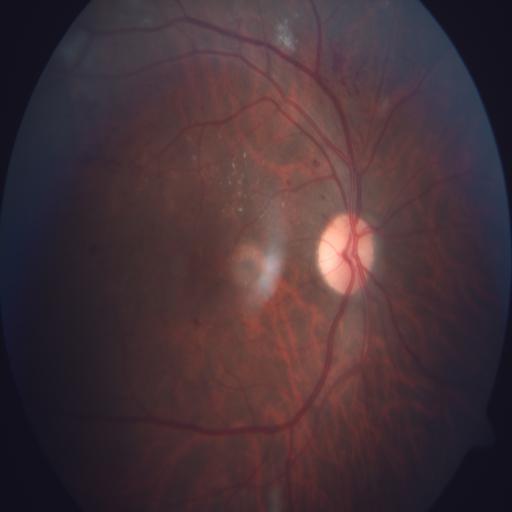 Two findings. Findings consistent with hemorrhagic retinopathy and microaneurysms.